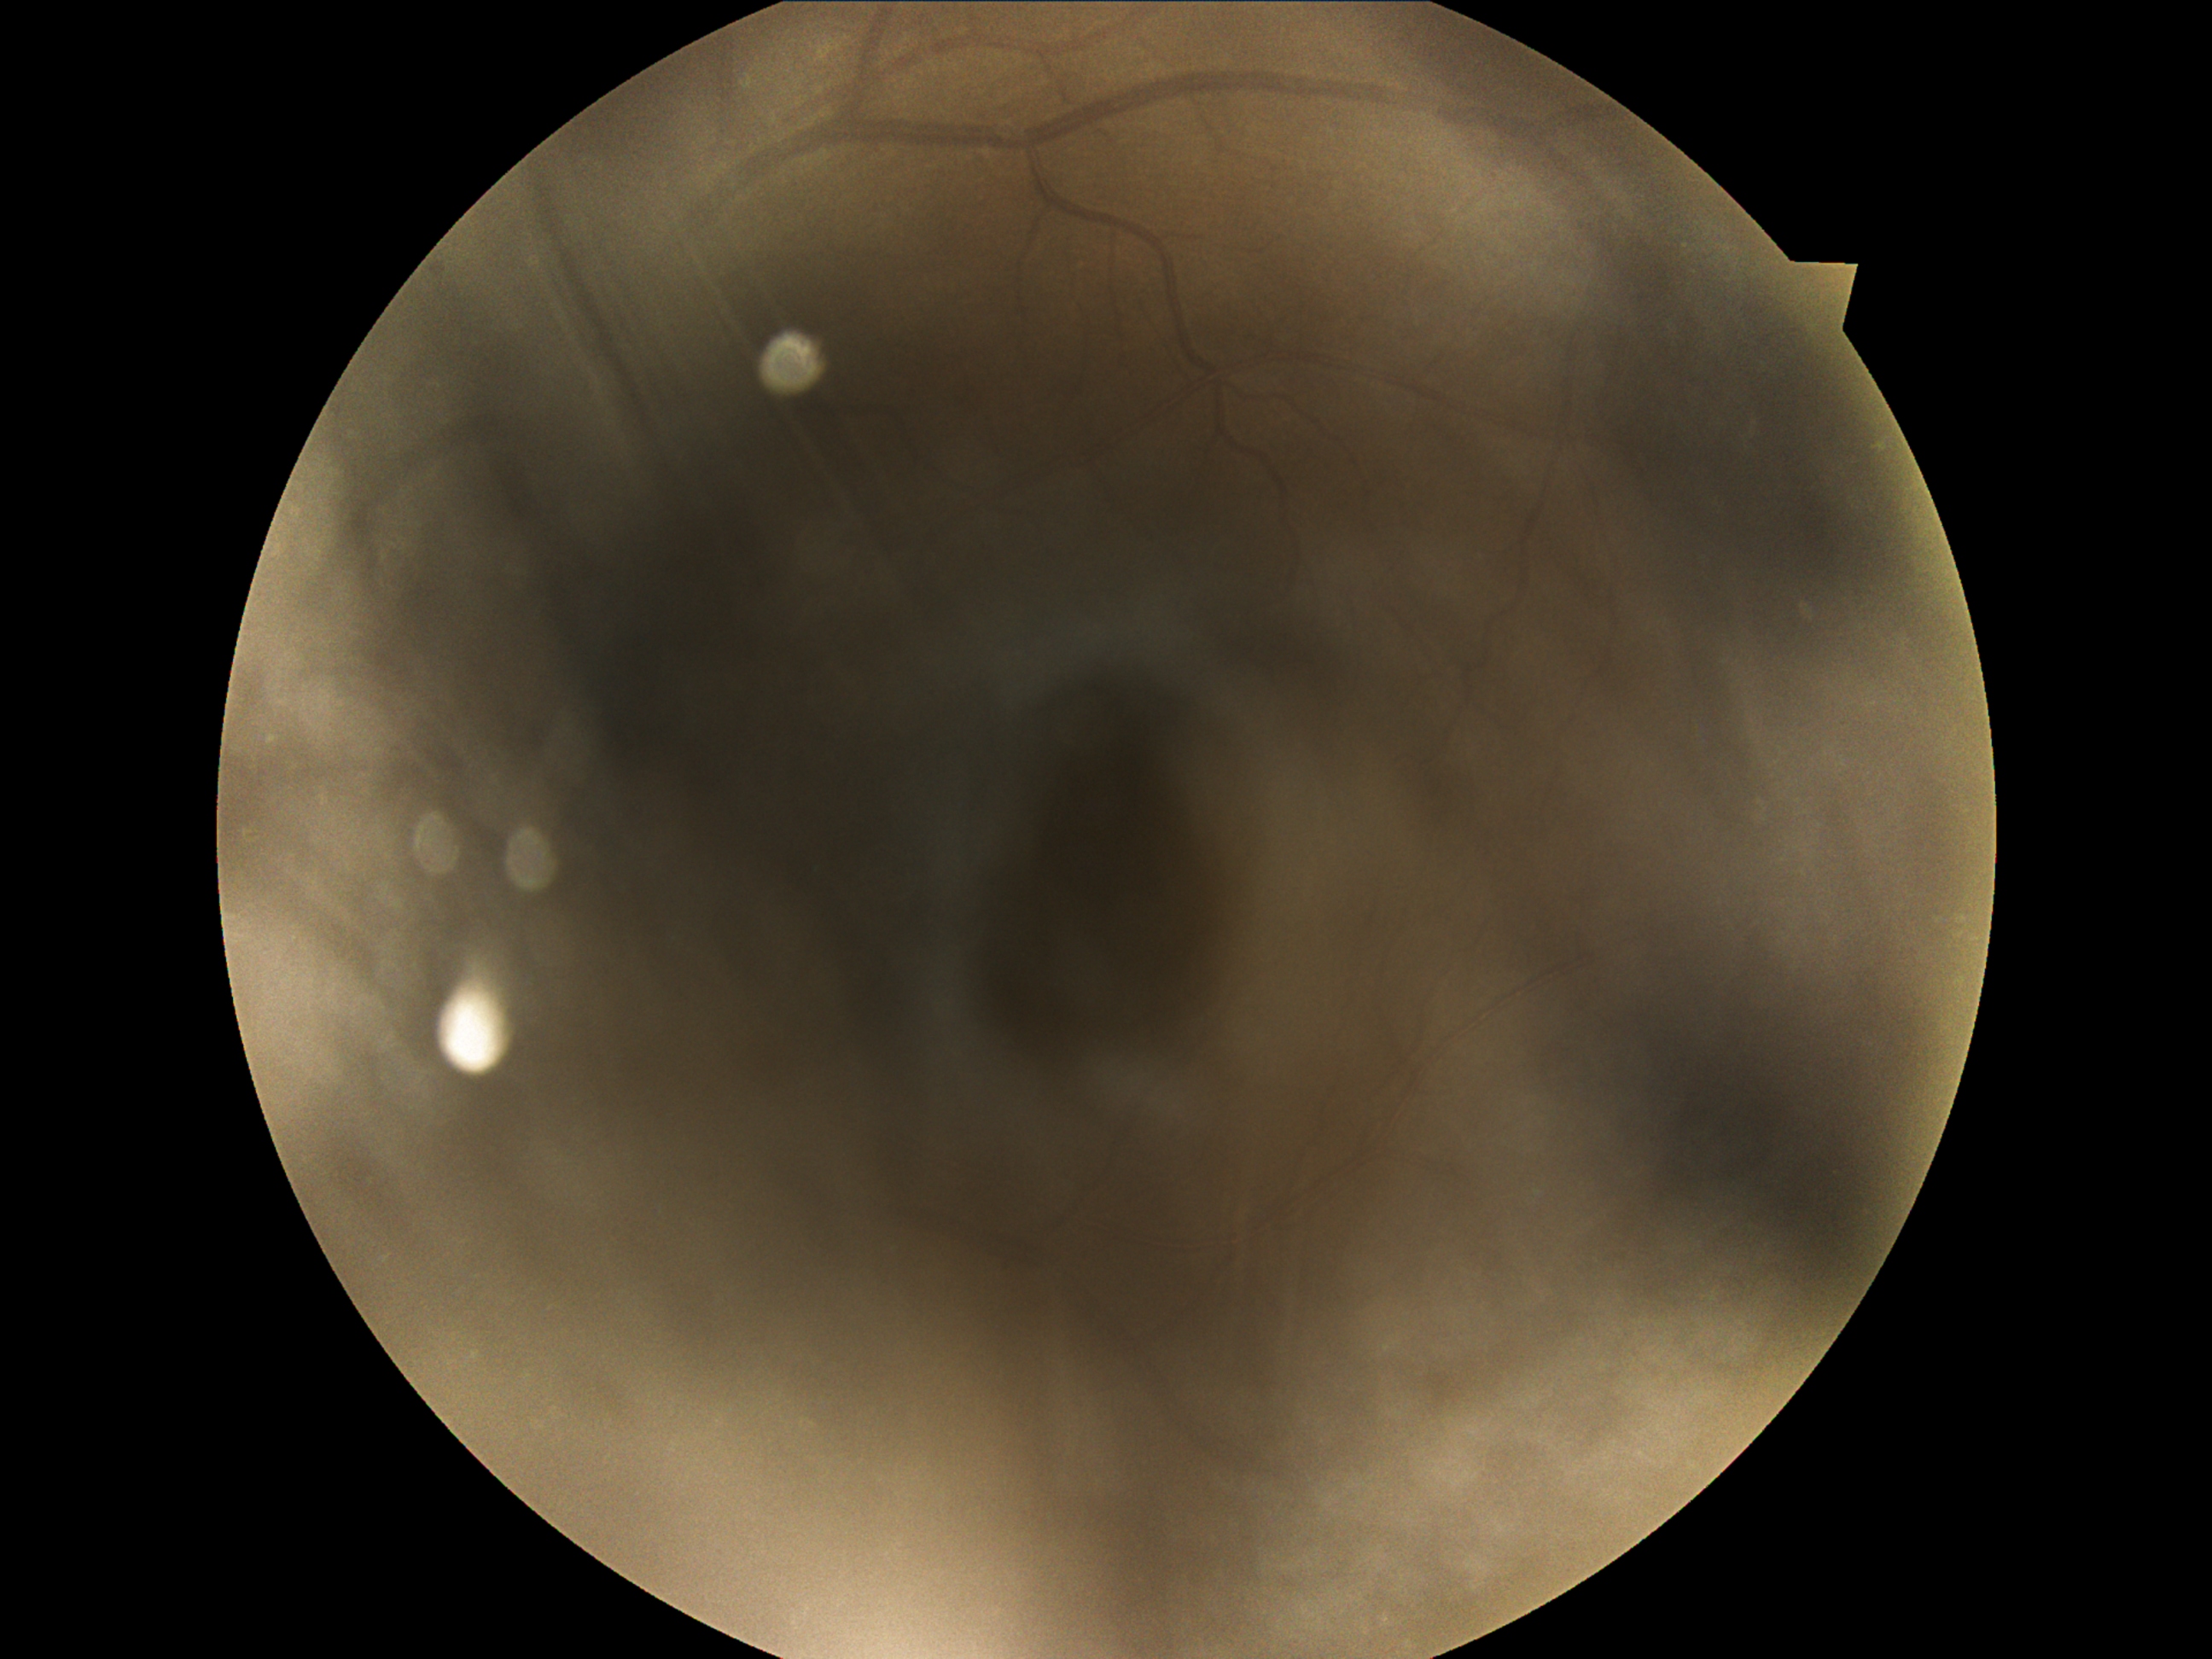

image quality: below grading threshold, diabetic retinopathy grade: ungradable.